2352x1568. Retinal fundus photograph: 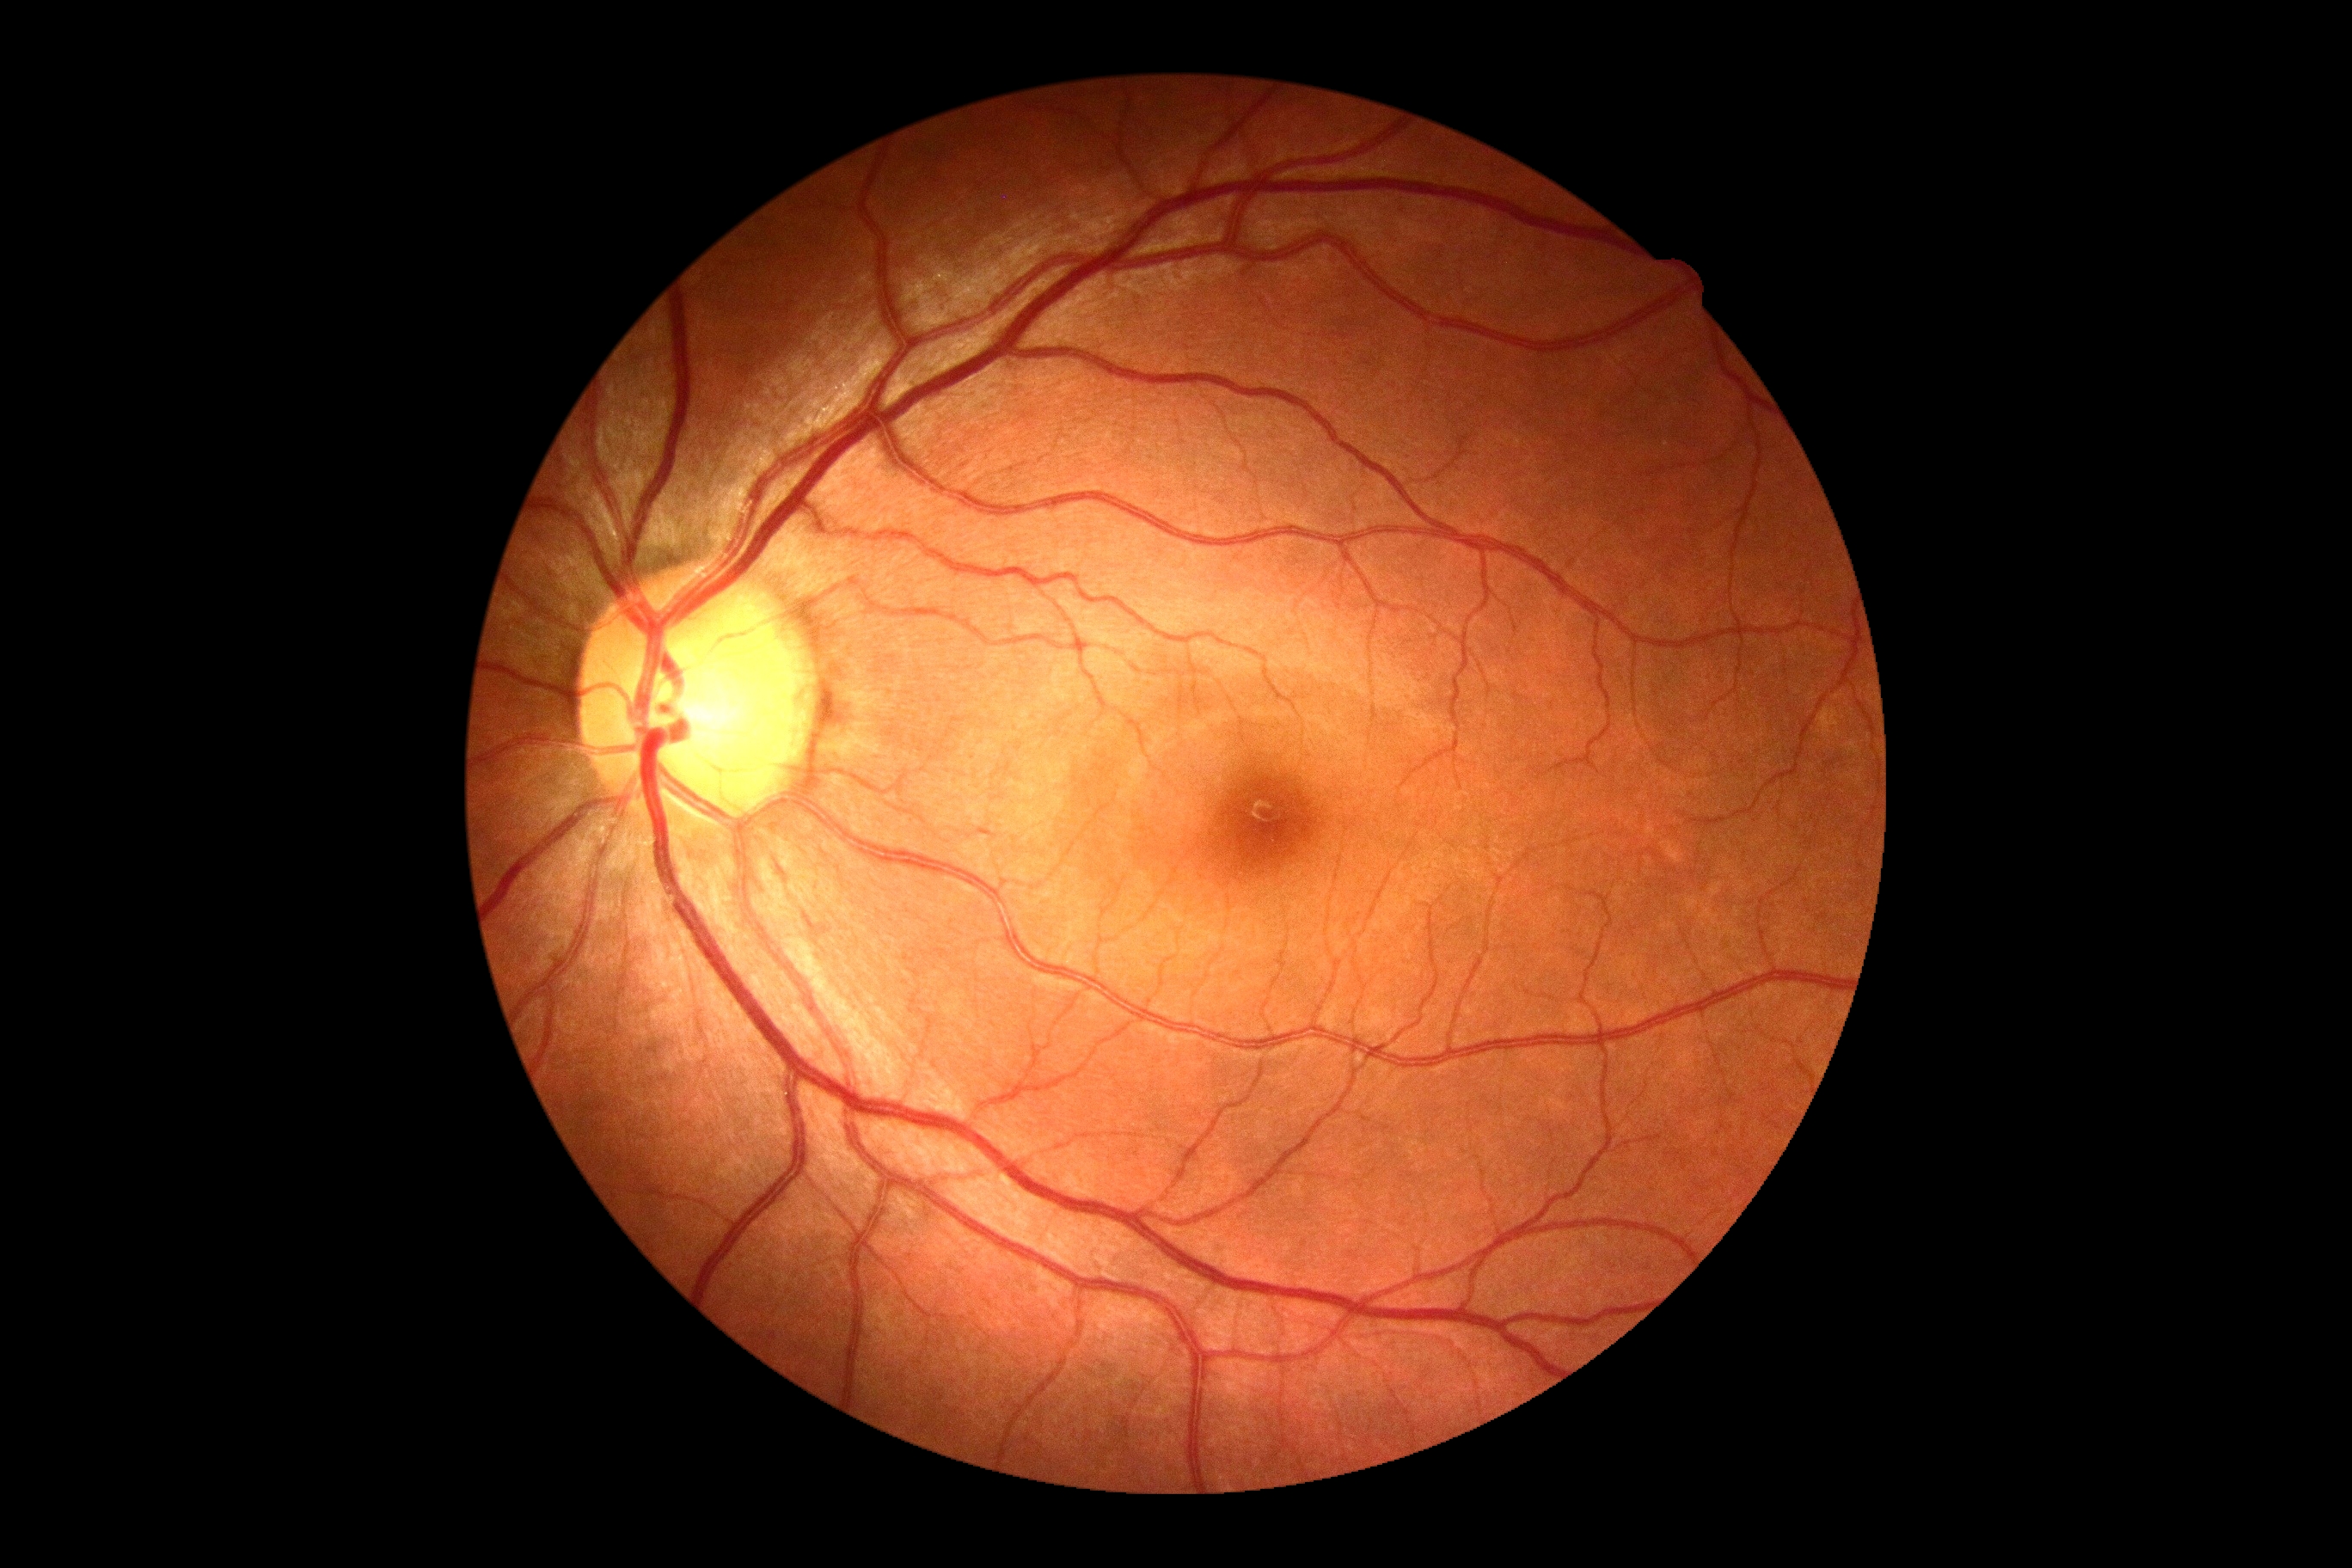
No apparent diabetic retinopathy. DR grade: 0.